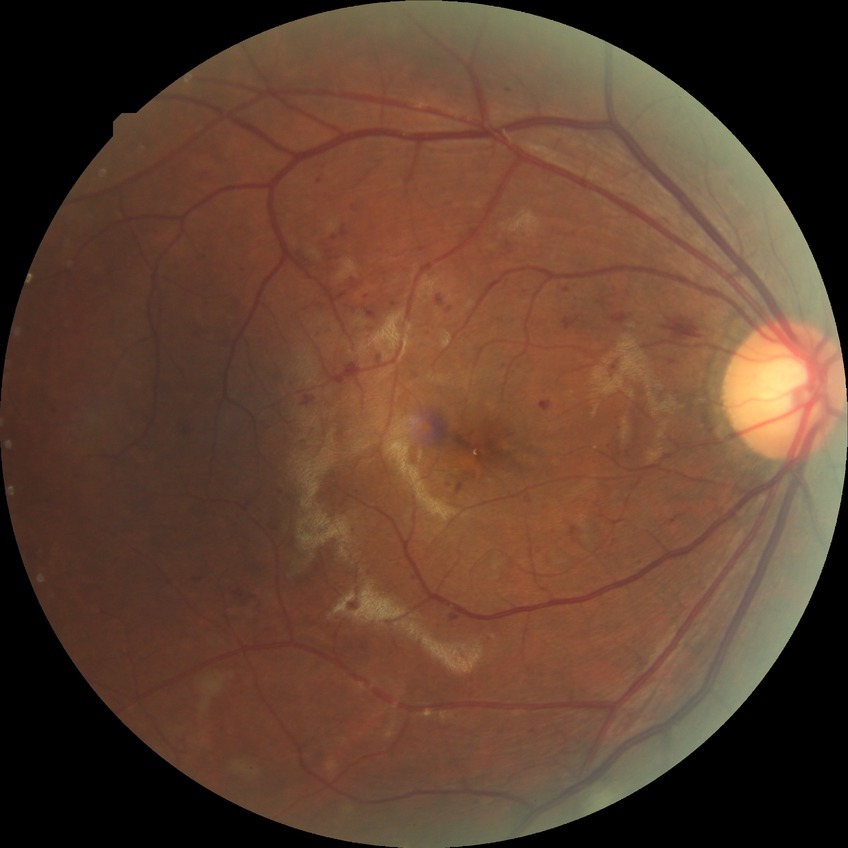
Diabetic retinopathy (DR): PPDR (pre-proliferative diabetic retinopathy).